Infant wide-field retinal image; acquired on the Natus RetCam Envision
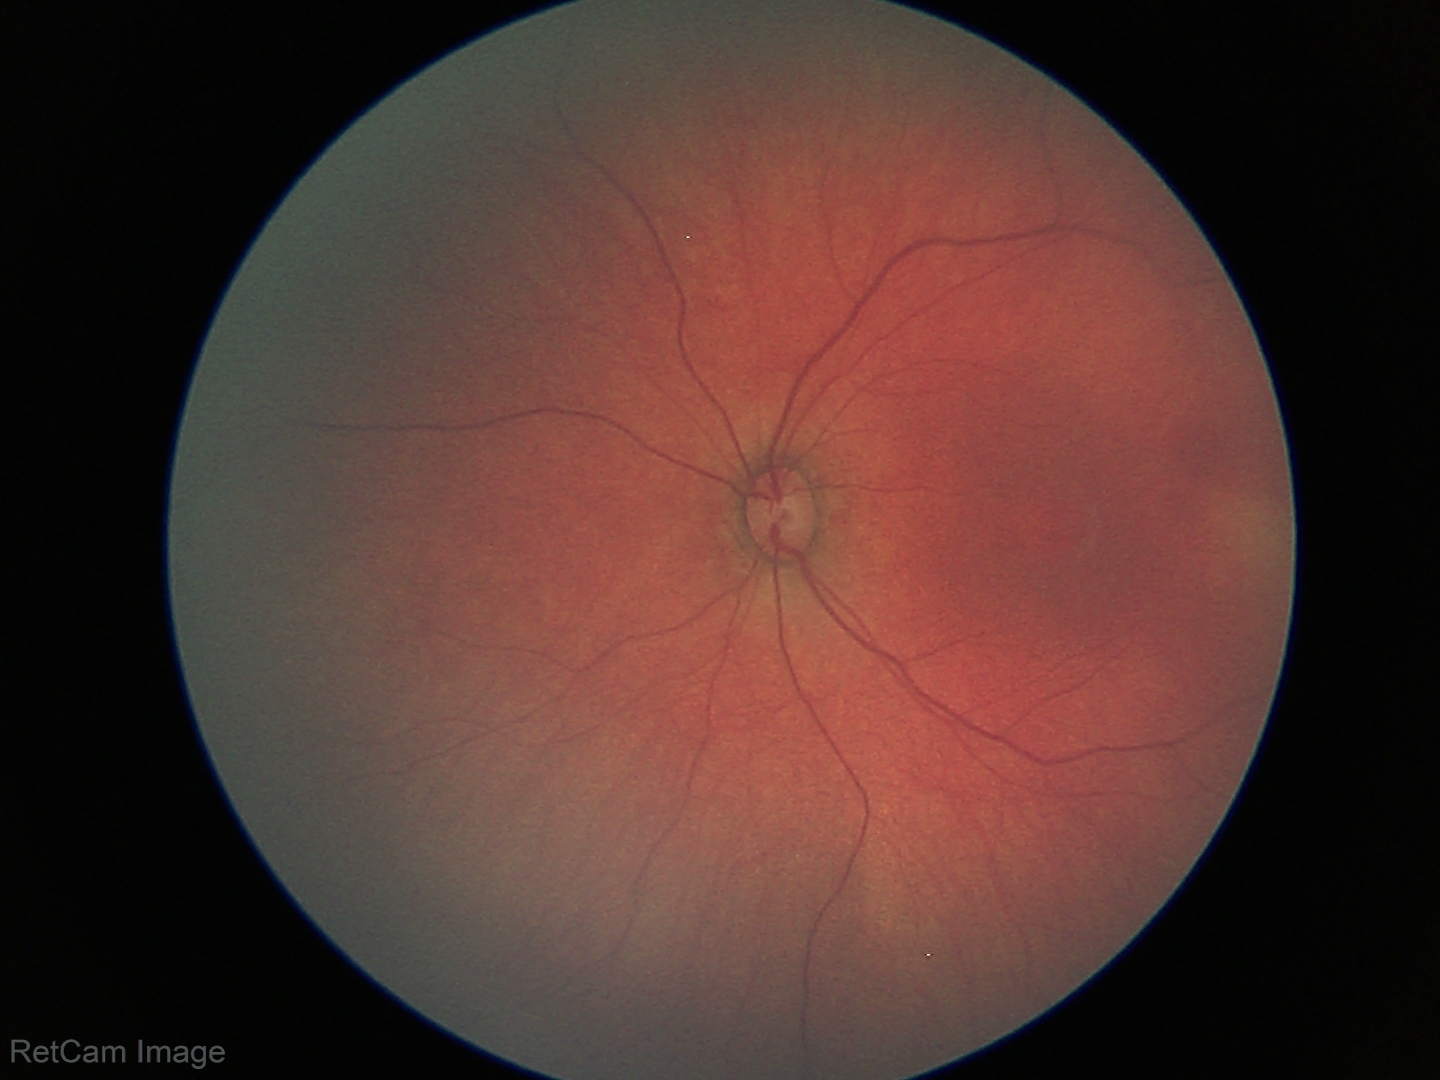 Examination with physiological retinal findings.